848x848px: 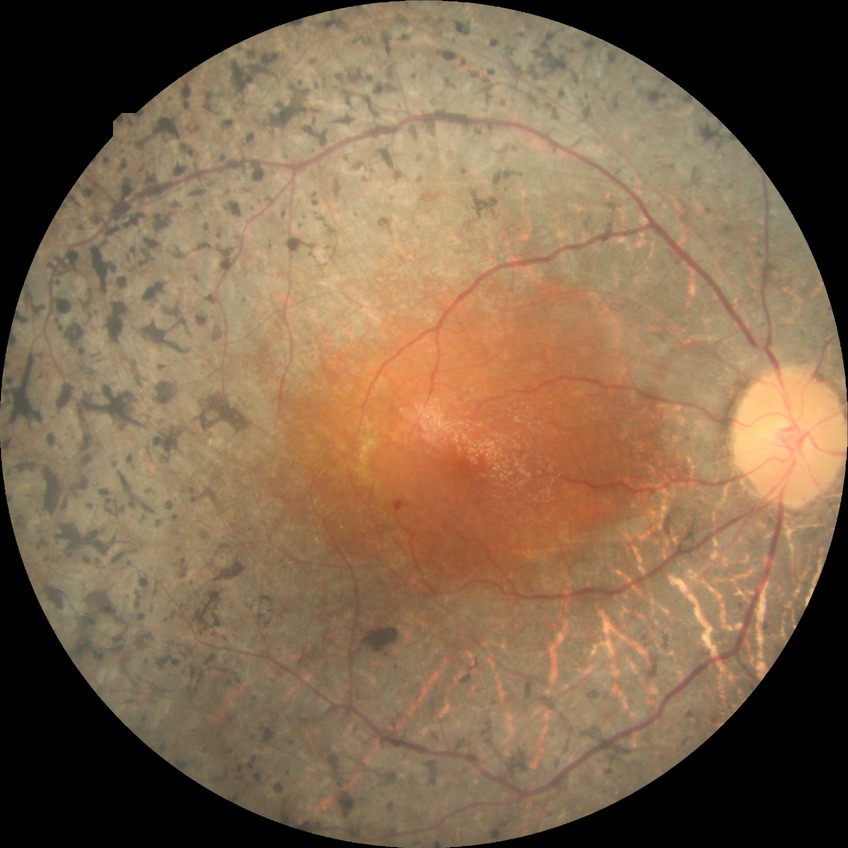

Diabetic retinopathy (DR) is no diabetic retinopathy (NDR).